848x848: 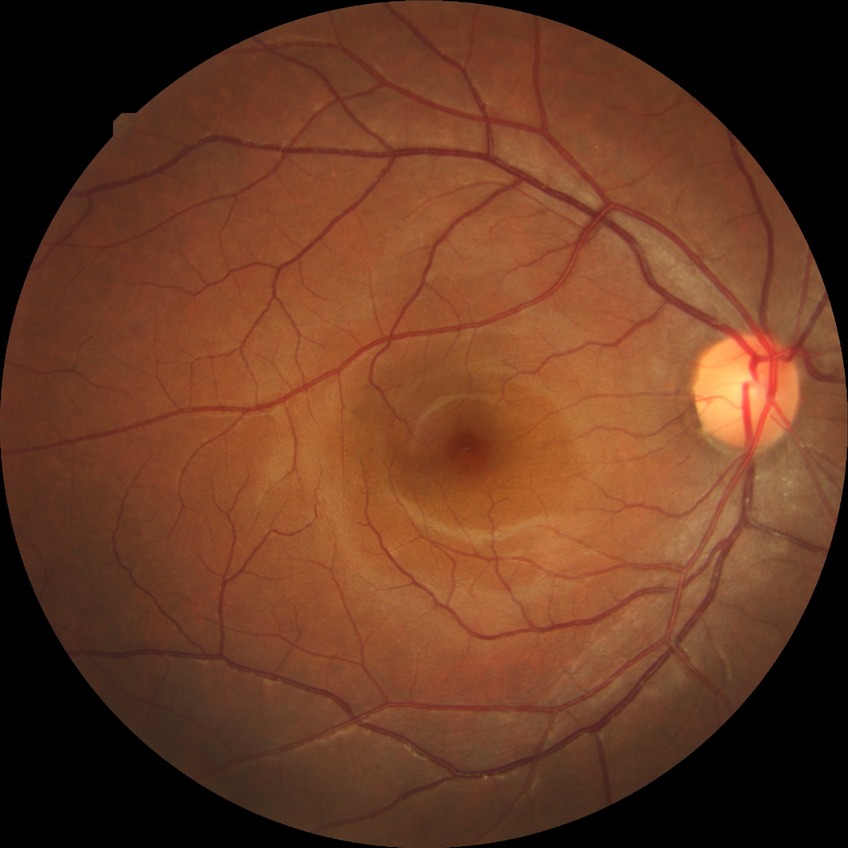   davis_grade: NDR